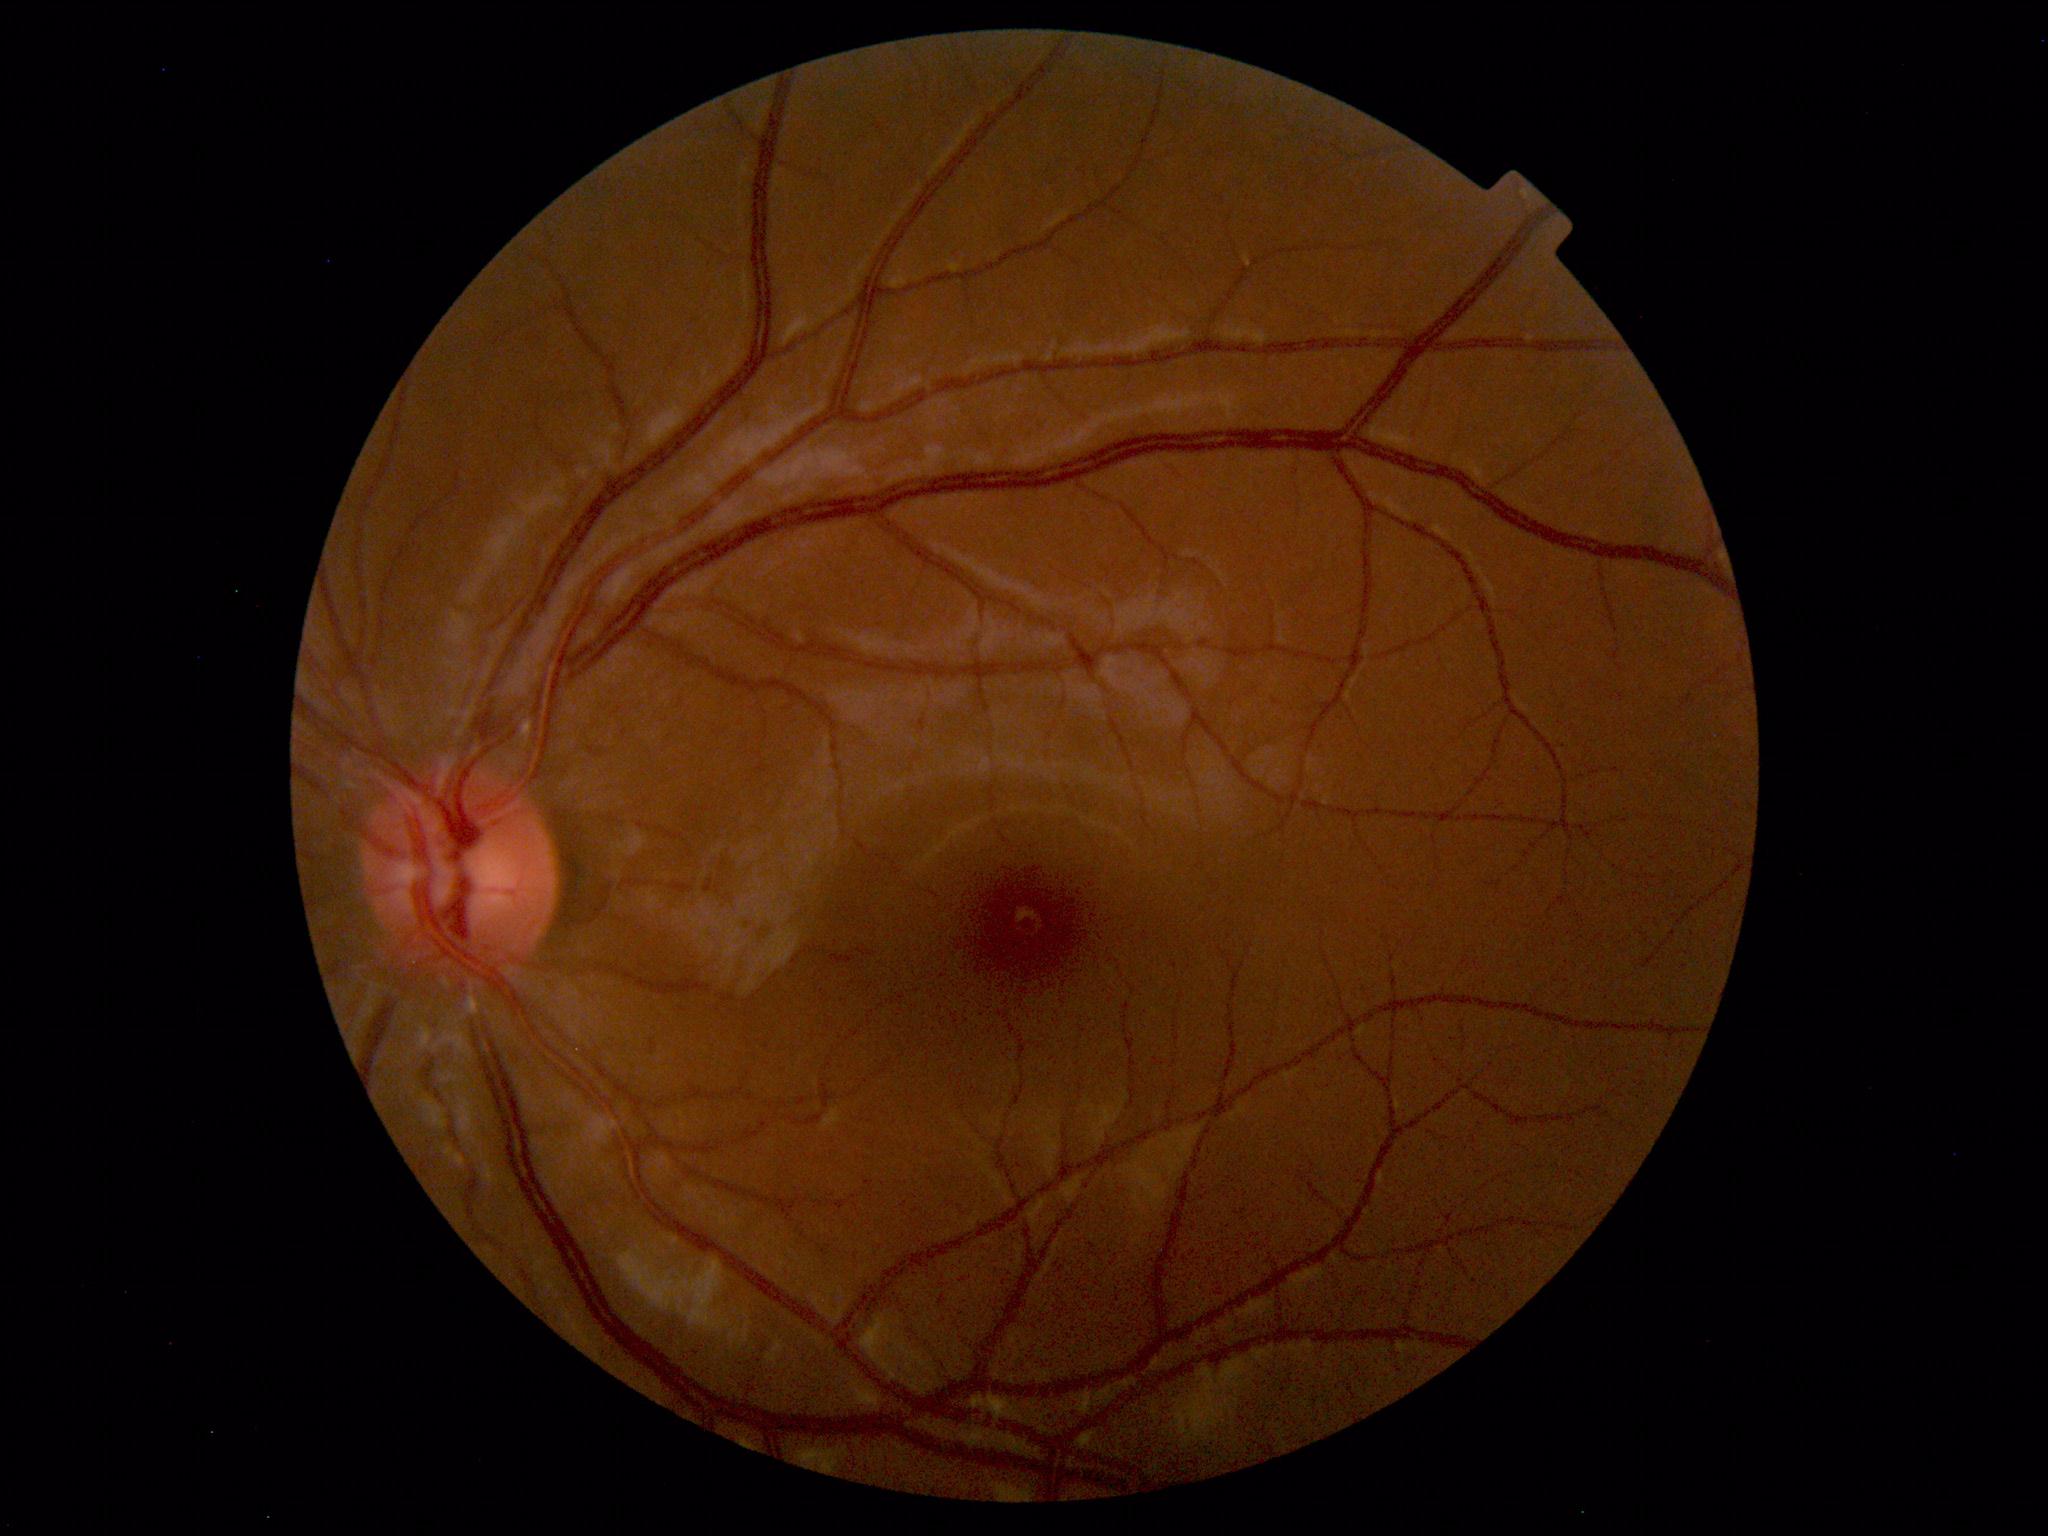

Diagnosis: normal.